Without pupil dilation, modified Davis classification — 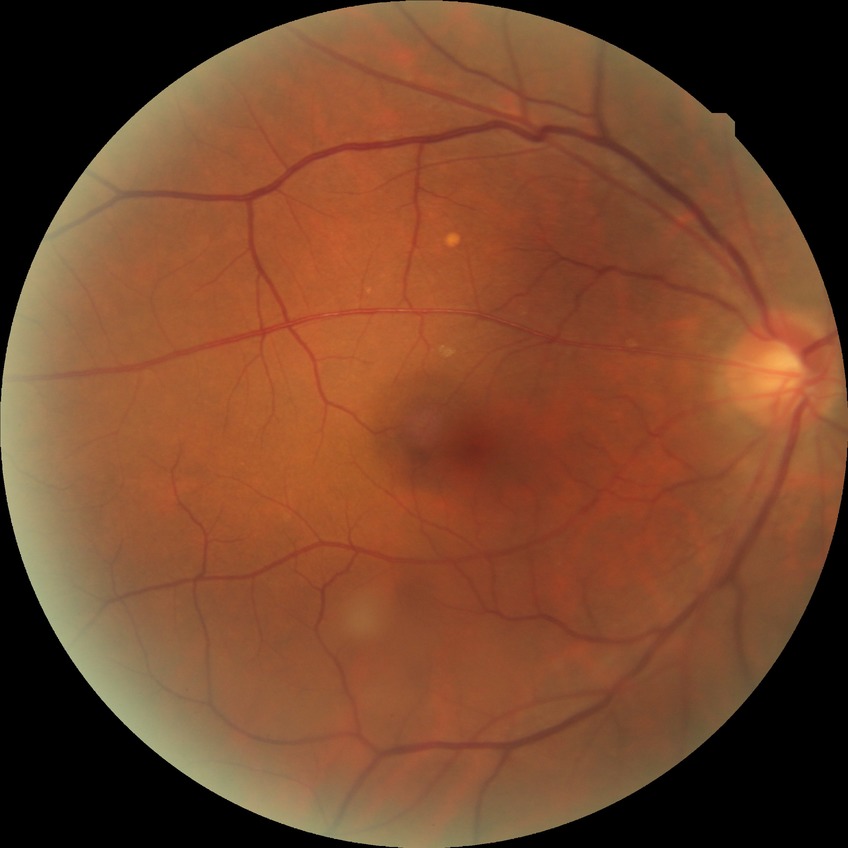
diabetic retinopathy stage@no diabetic retinopathy.